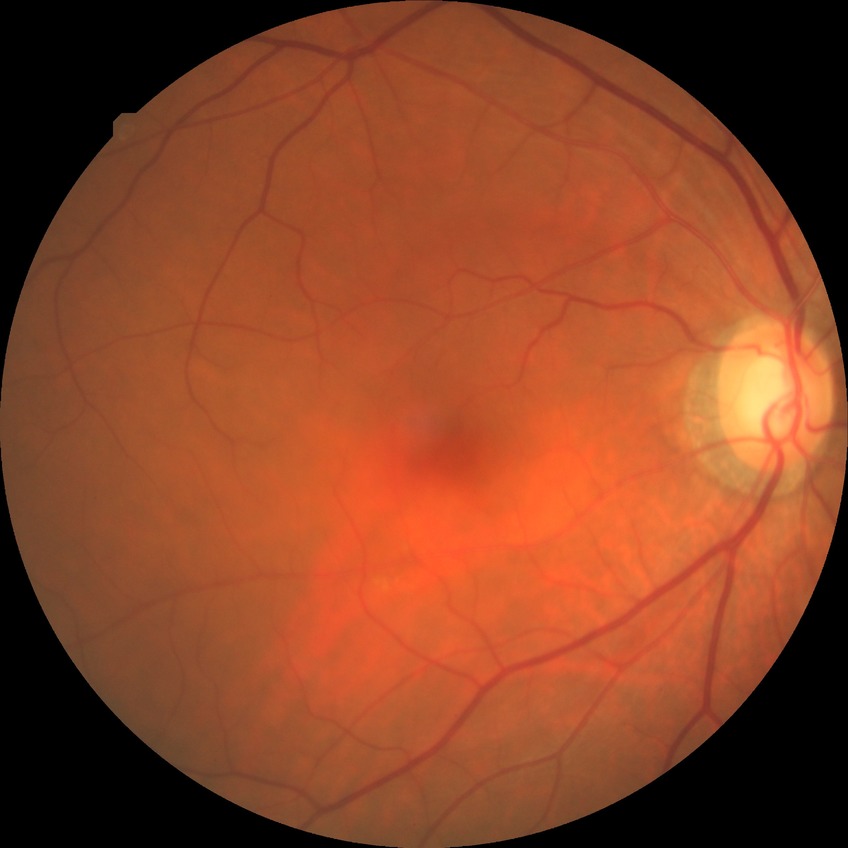
diabetic retinopathy (DR) = no diabetic retinopathy (NDR).